Wide-field contact fundus photograph of an infant:
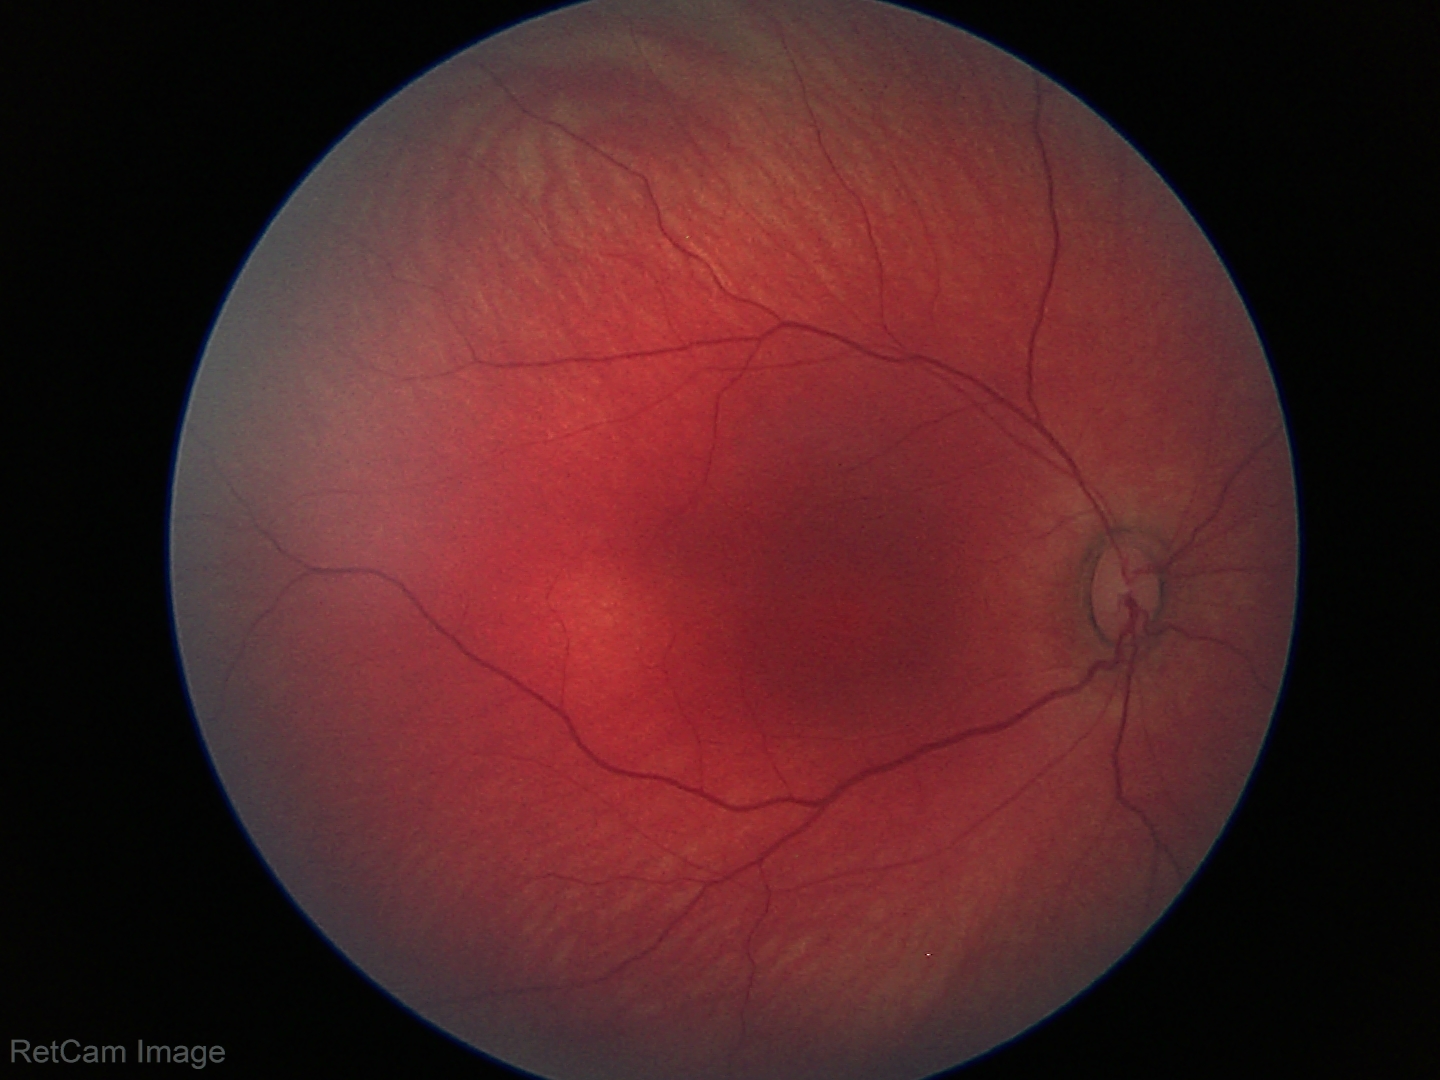

Screening examination with no abnormal retinal findings.